NIDEK AFC-230; graded on the modified Davis scale: 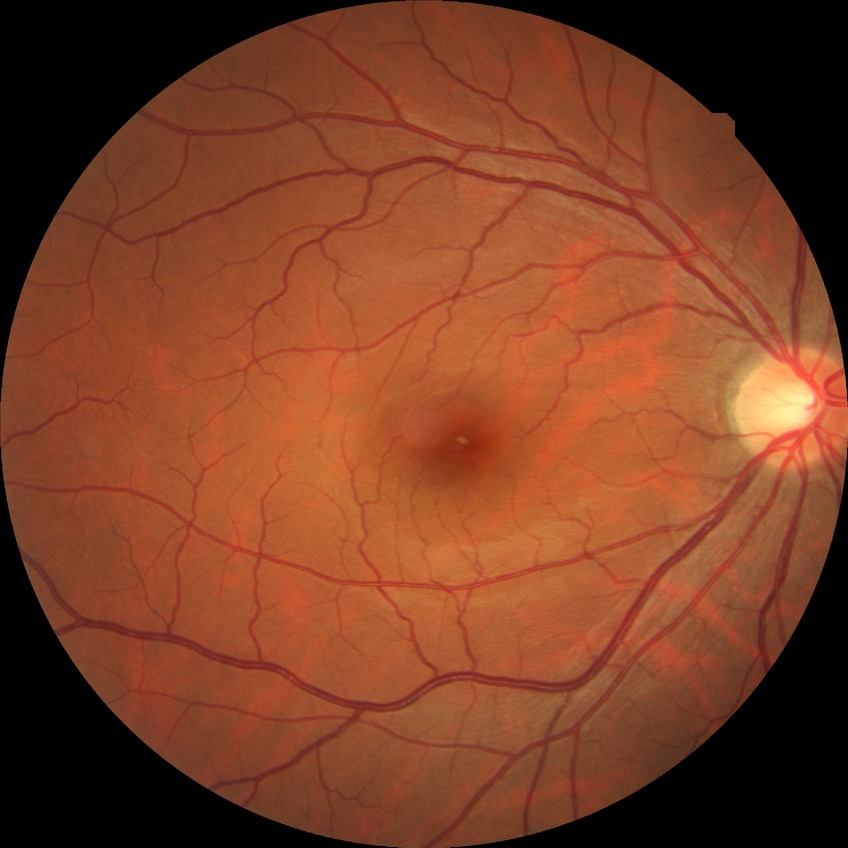

Diabetic retinopathy severity: no diabetic retinopathy.